45° FOV. Color fundus image
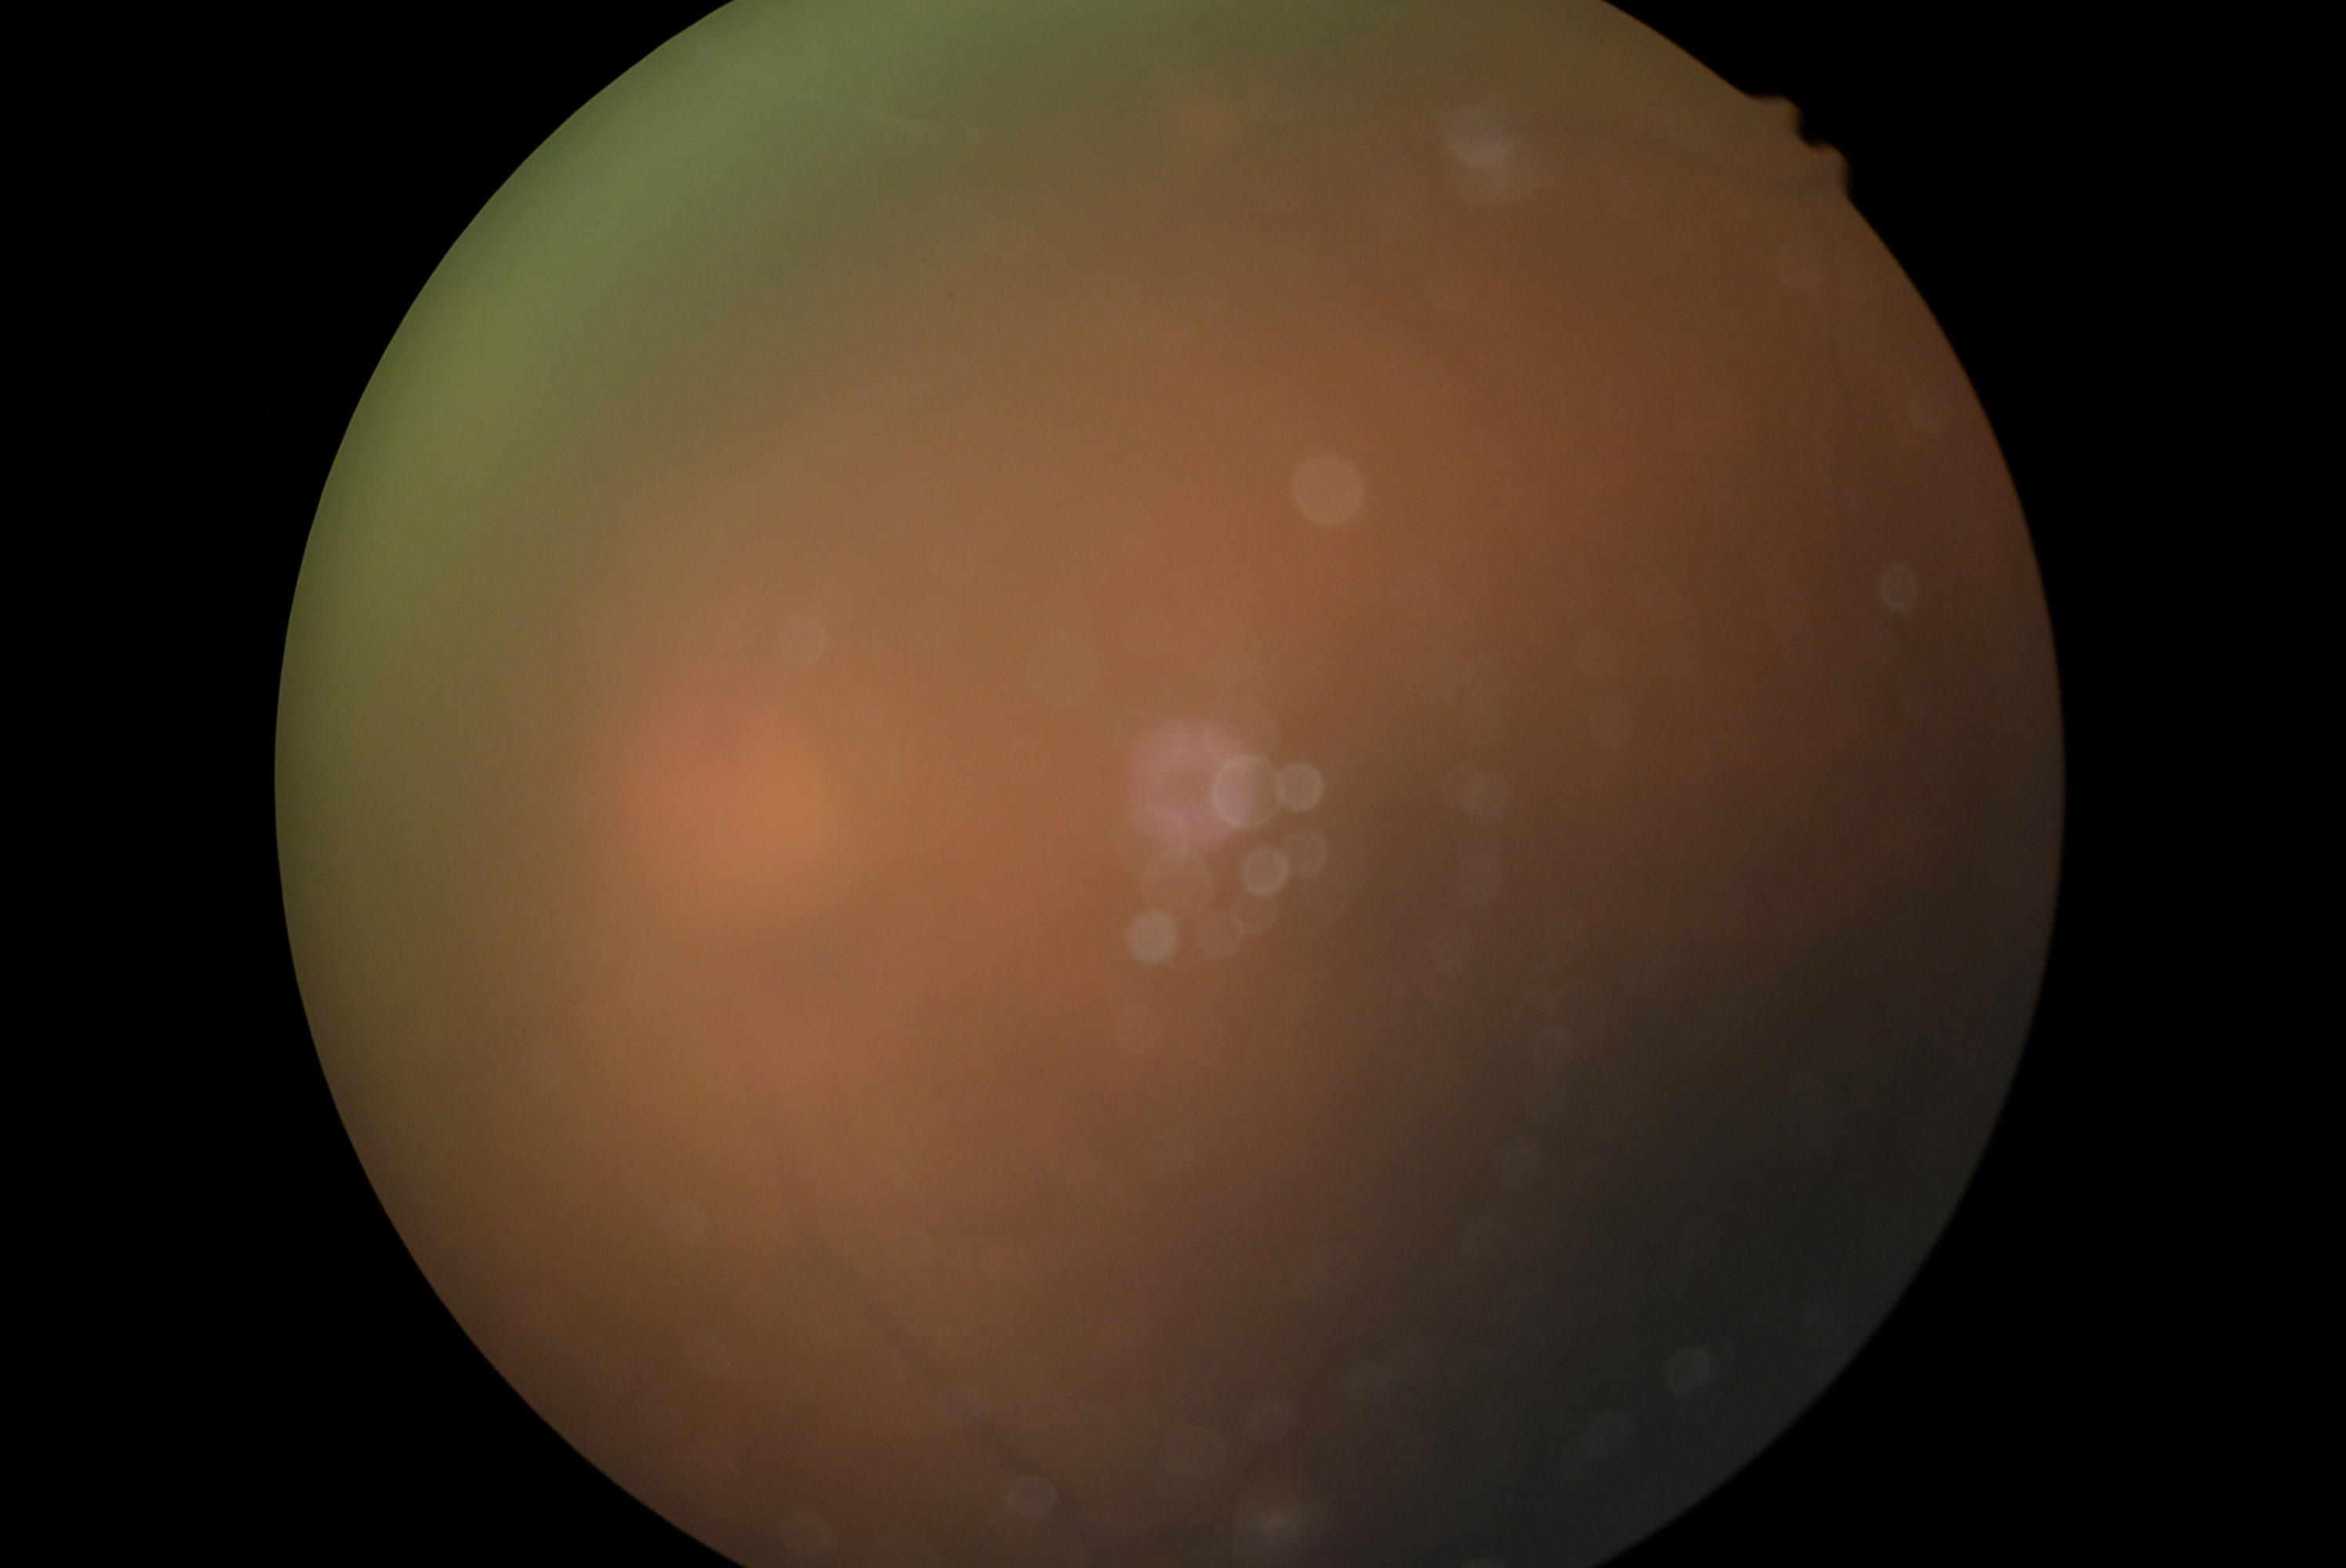   dr_grade: ungradable
  quality: too poor for DR grading